FOV: 45 degrees: 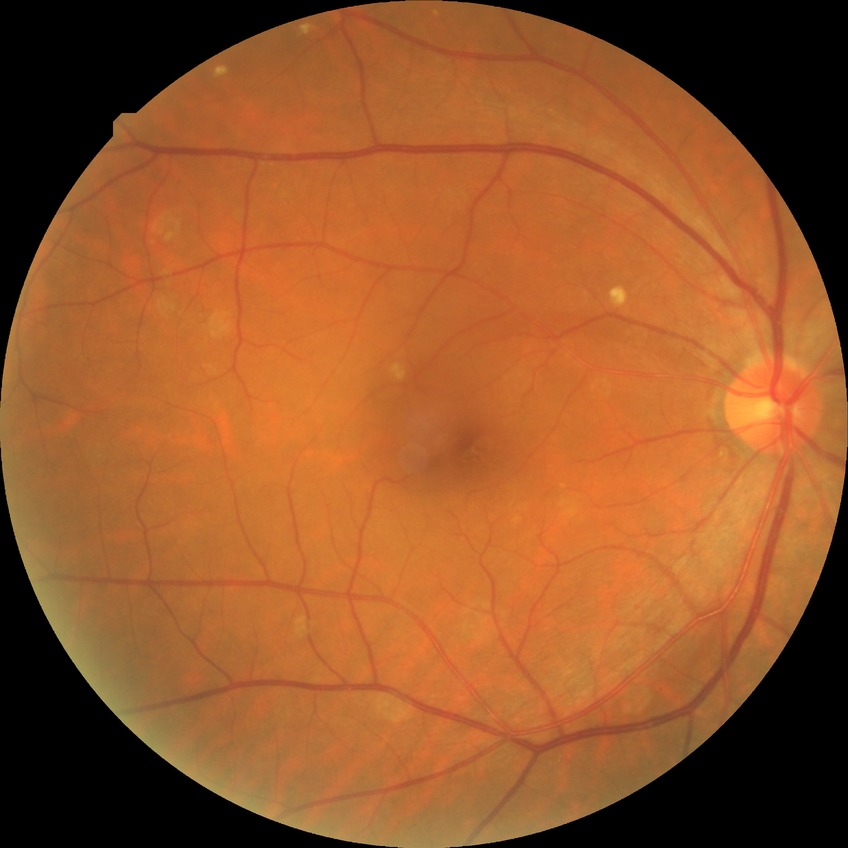 Diabetic retinopathy (DR): NDR (no diabetic retinopathy).